DR severity per modified Davis staging, nonmydriatic fundus photograph.
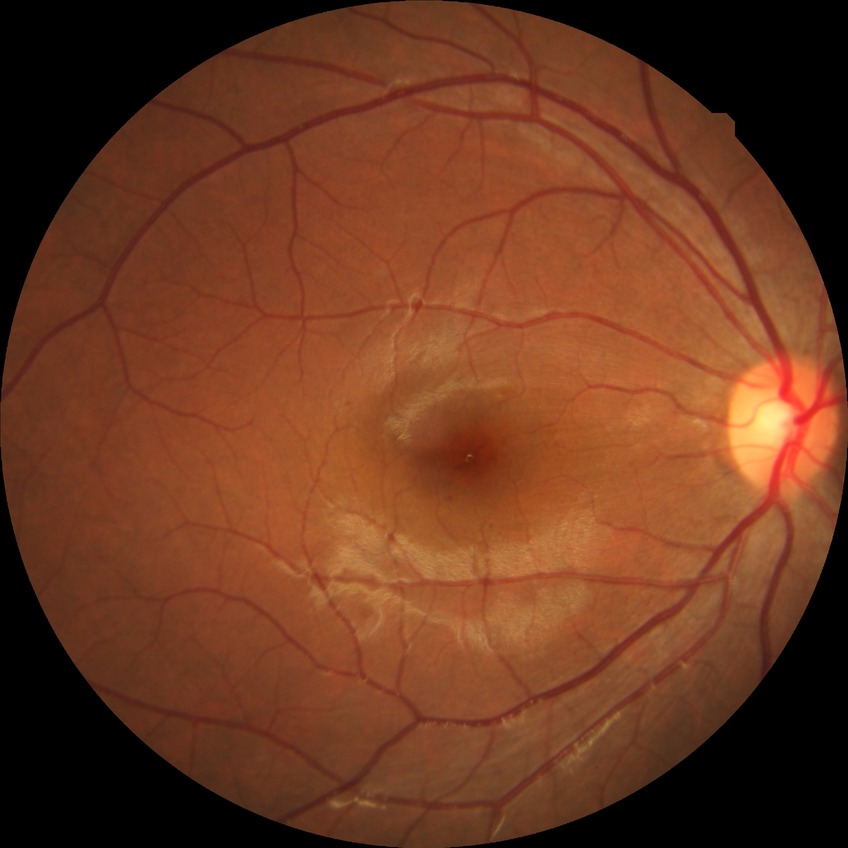

  davis_grade: no diabetic retinopathy (NDR)